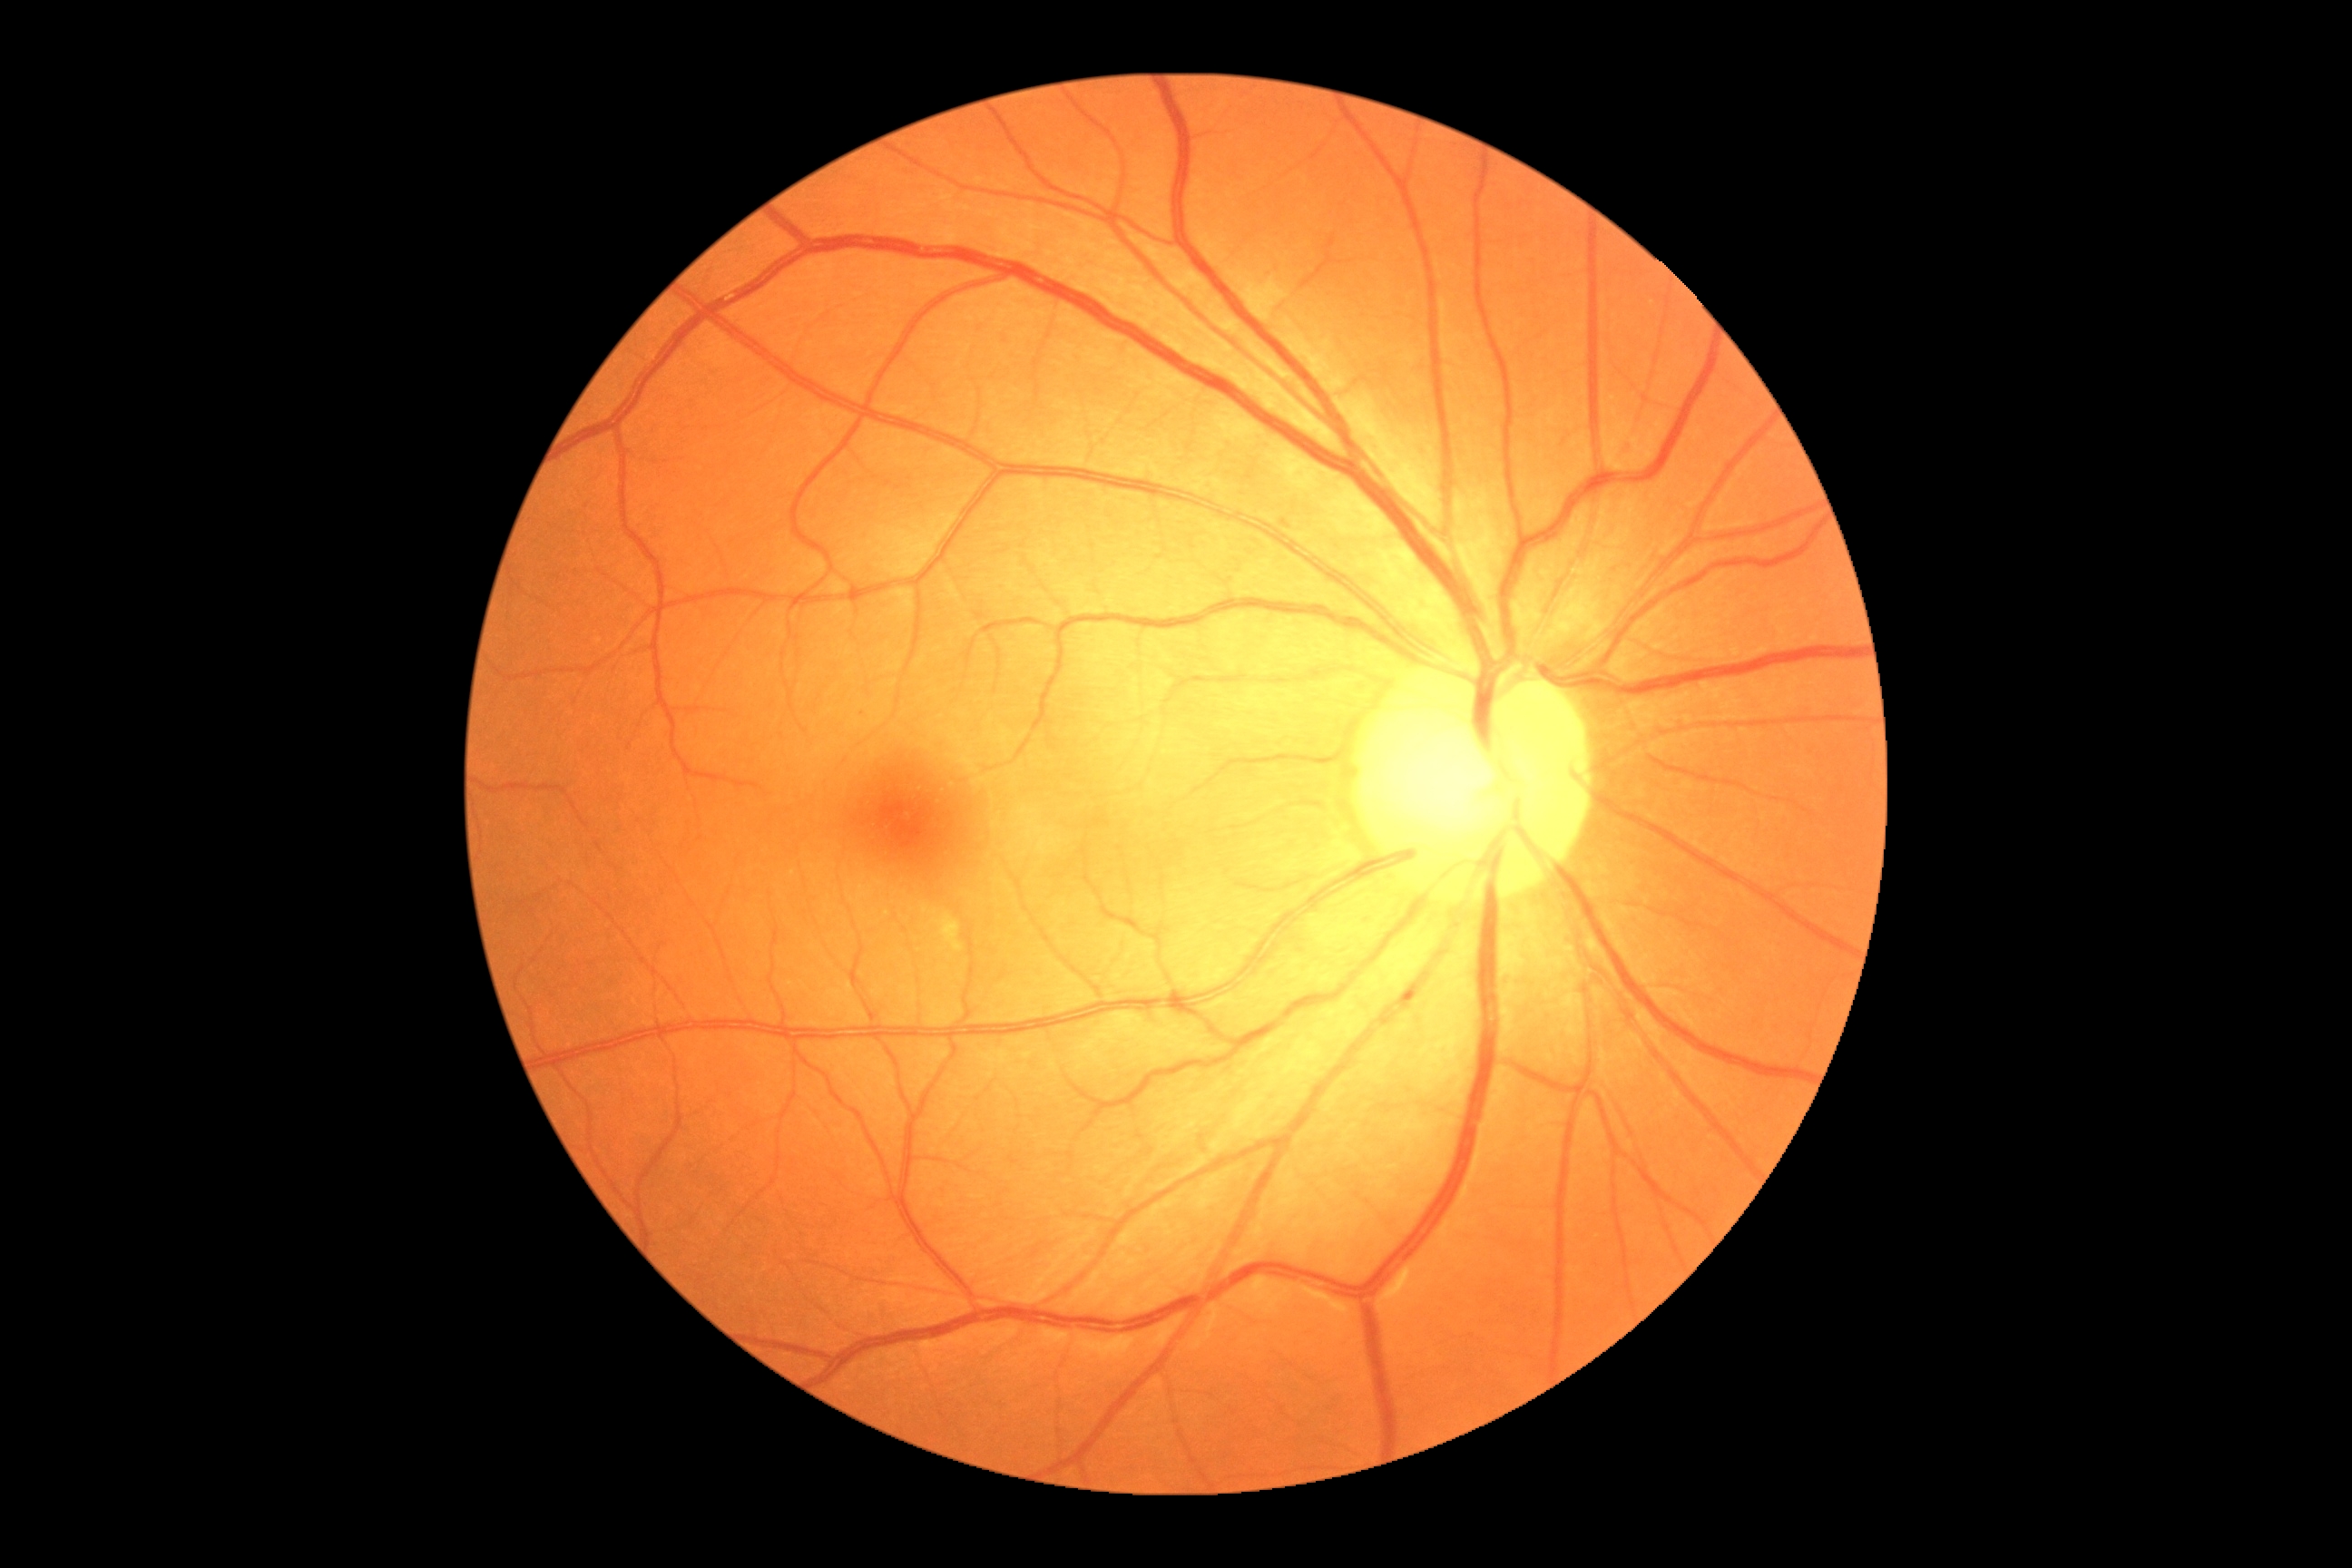 diabetic retinopathy severity: 0.